Modified Davis grading
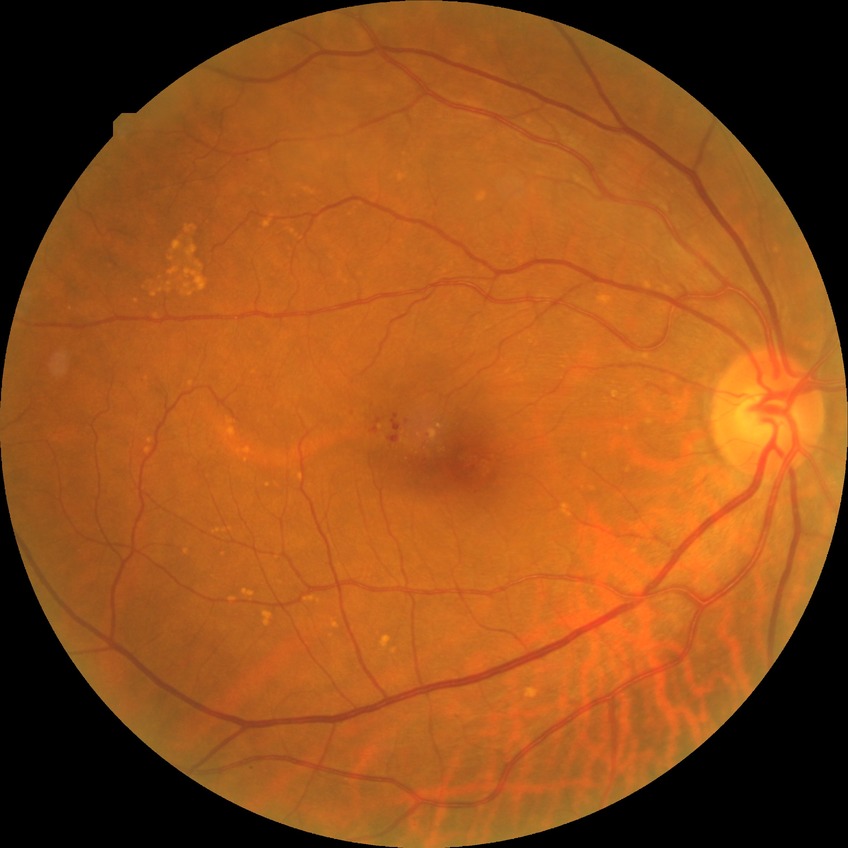
Diabetic retinopathy (DR) is simple diabetic retinopathy (SDR).
Disease class: non-proliferative diabetic retinopathy.